Color fundus image, mydriatic (tropicamide and phenylephrine), posterior pole view, image size 2228x1652.
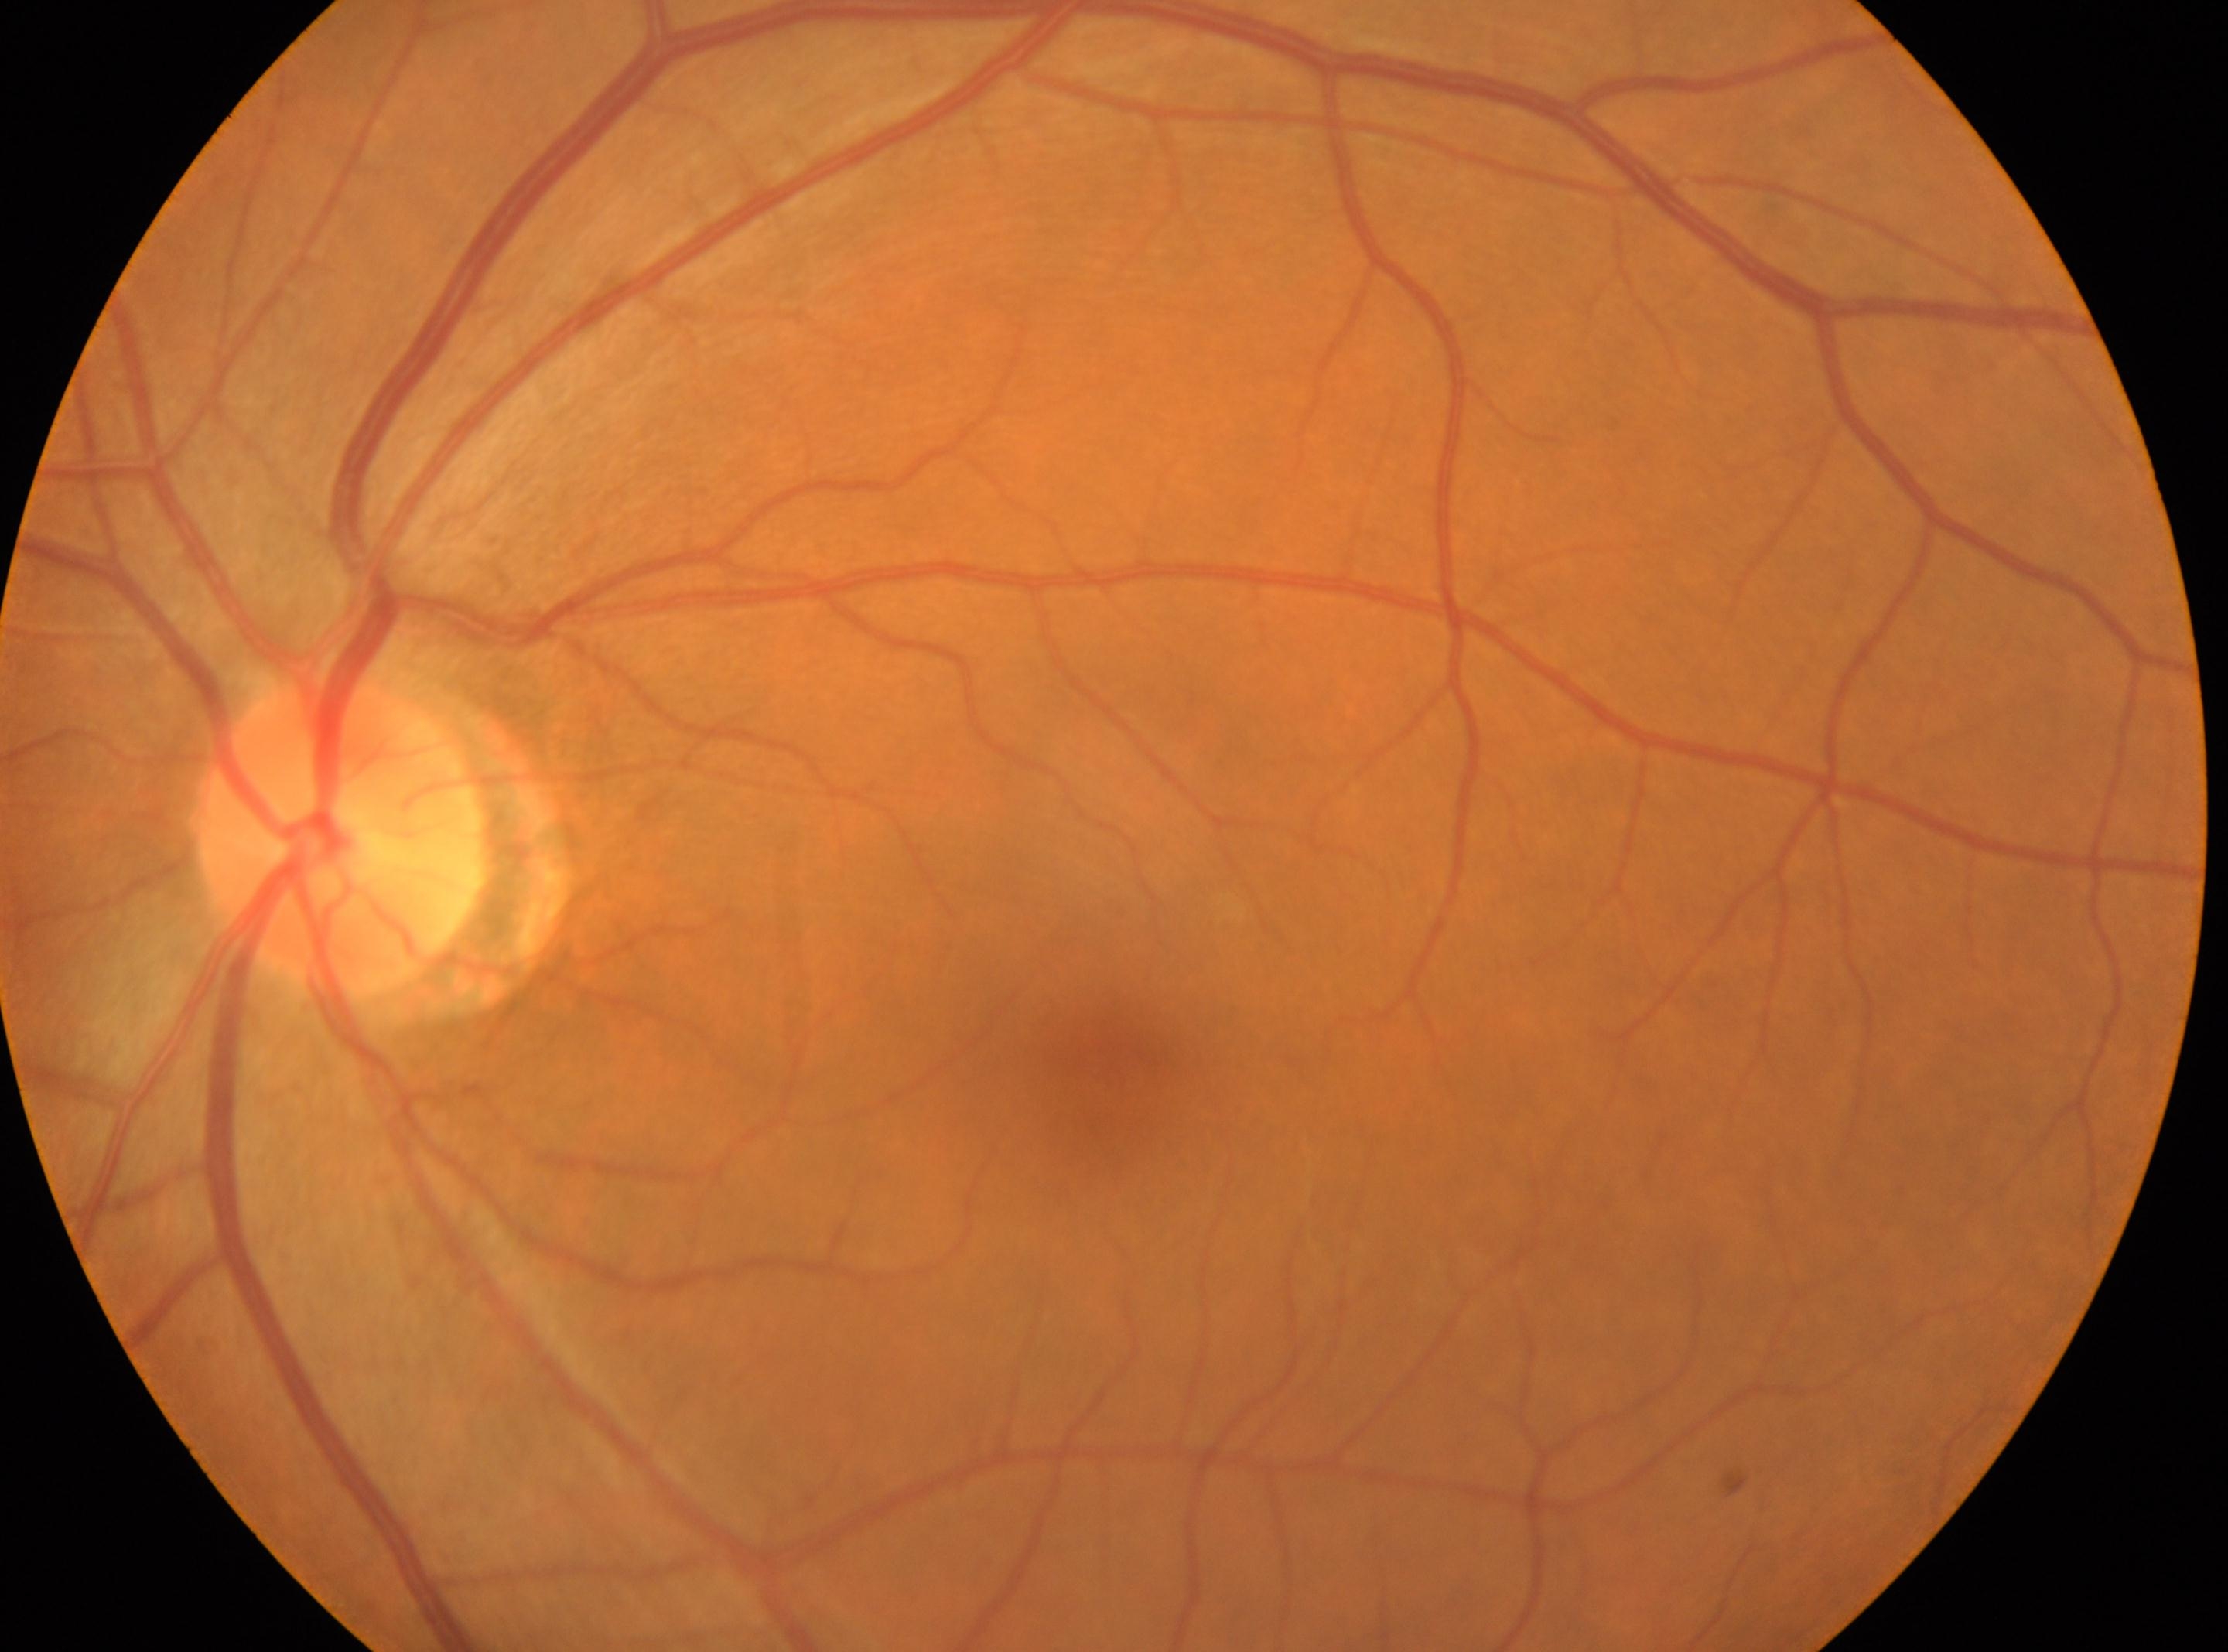 – DR grade · 0
– macula center · (x: 1114, y: 1077)
– ONH · (x: 340, y: 838)
– laterality · the left eye